Wide-field fundus photograph of an infant; 640 x 480 pixels; camera: Clarity RetCam 3 (130° FOV).
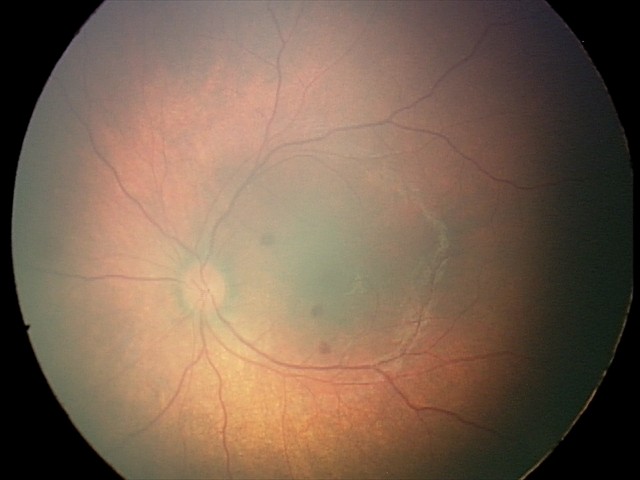
Diagnosis from this screening exam: retinal hemorrhages.